Non-mydriatic. Optic disc region crop. Camera: Nidek AFC-330:
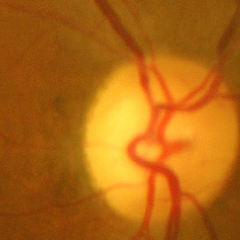
Color fundus photograph showing advanced glaucoma. Defined as near-total cupping of the optic nerve head, with or without severe visual field loss within the central 10 degrees of fixation.